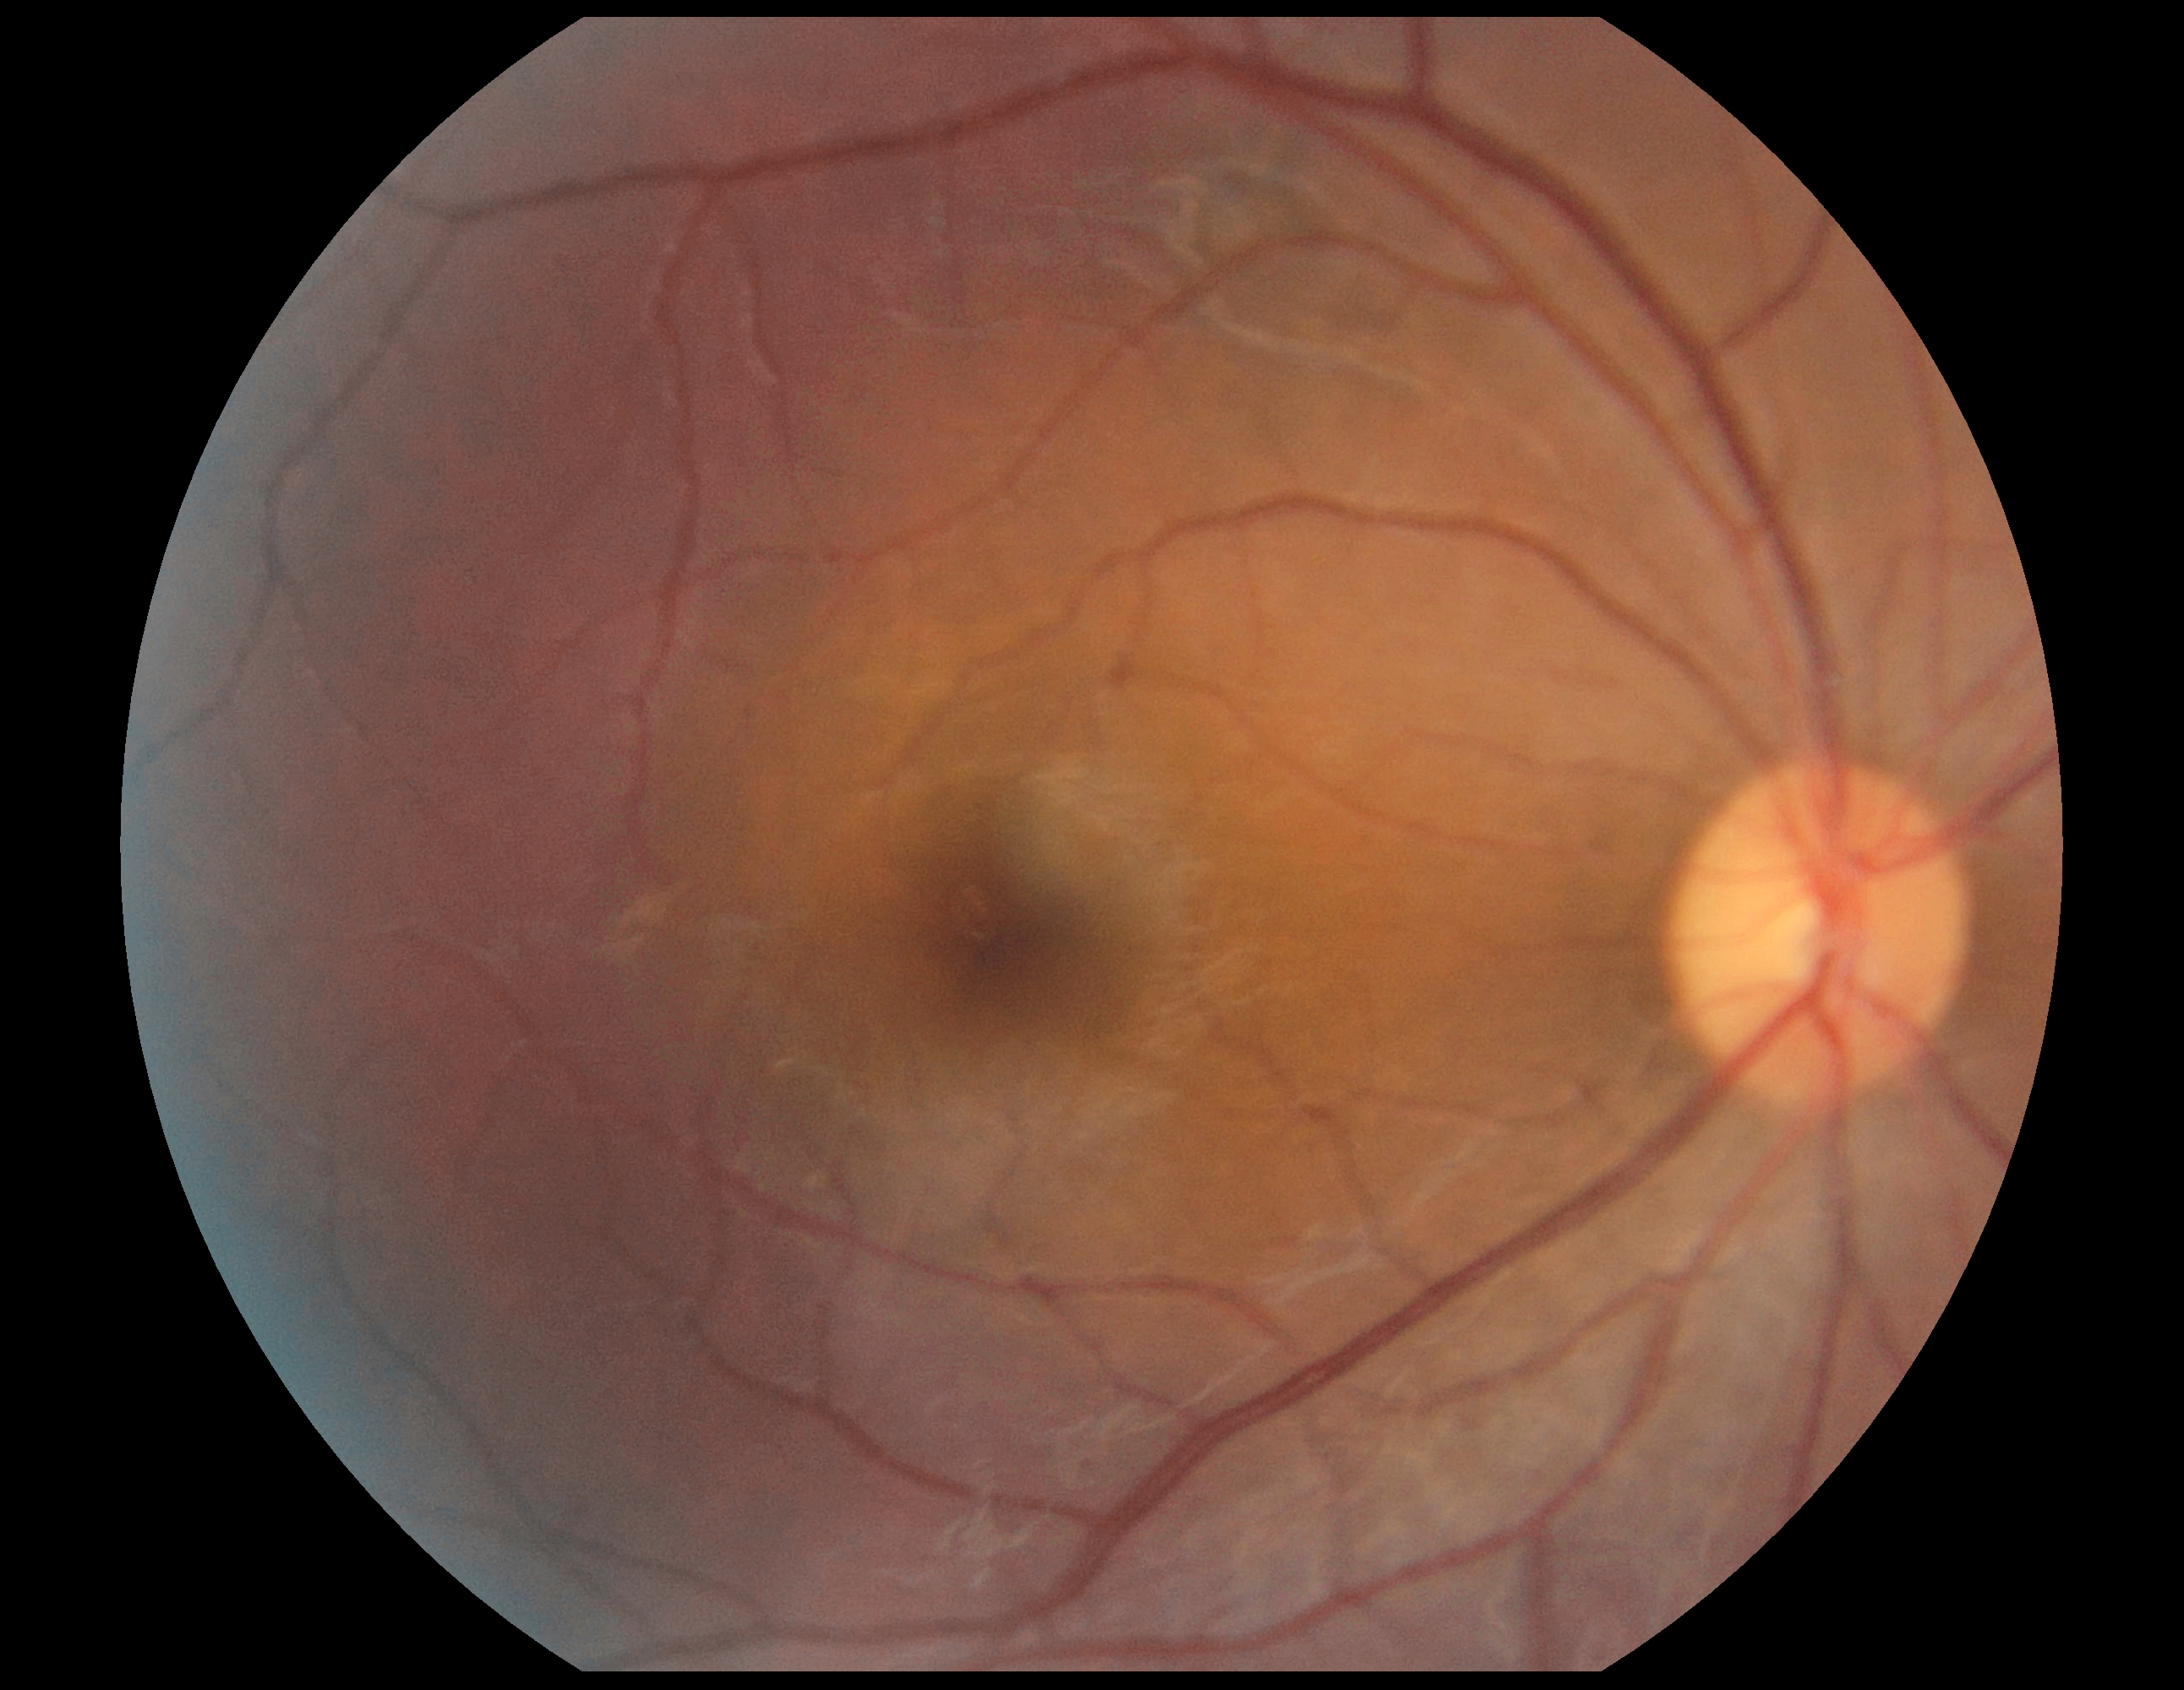

DR stage=grade 0 (no apparent retinopathy), DR impression=negative for DR.